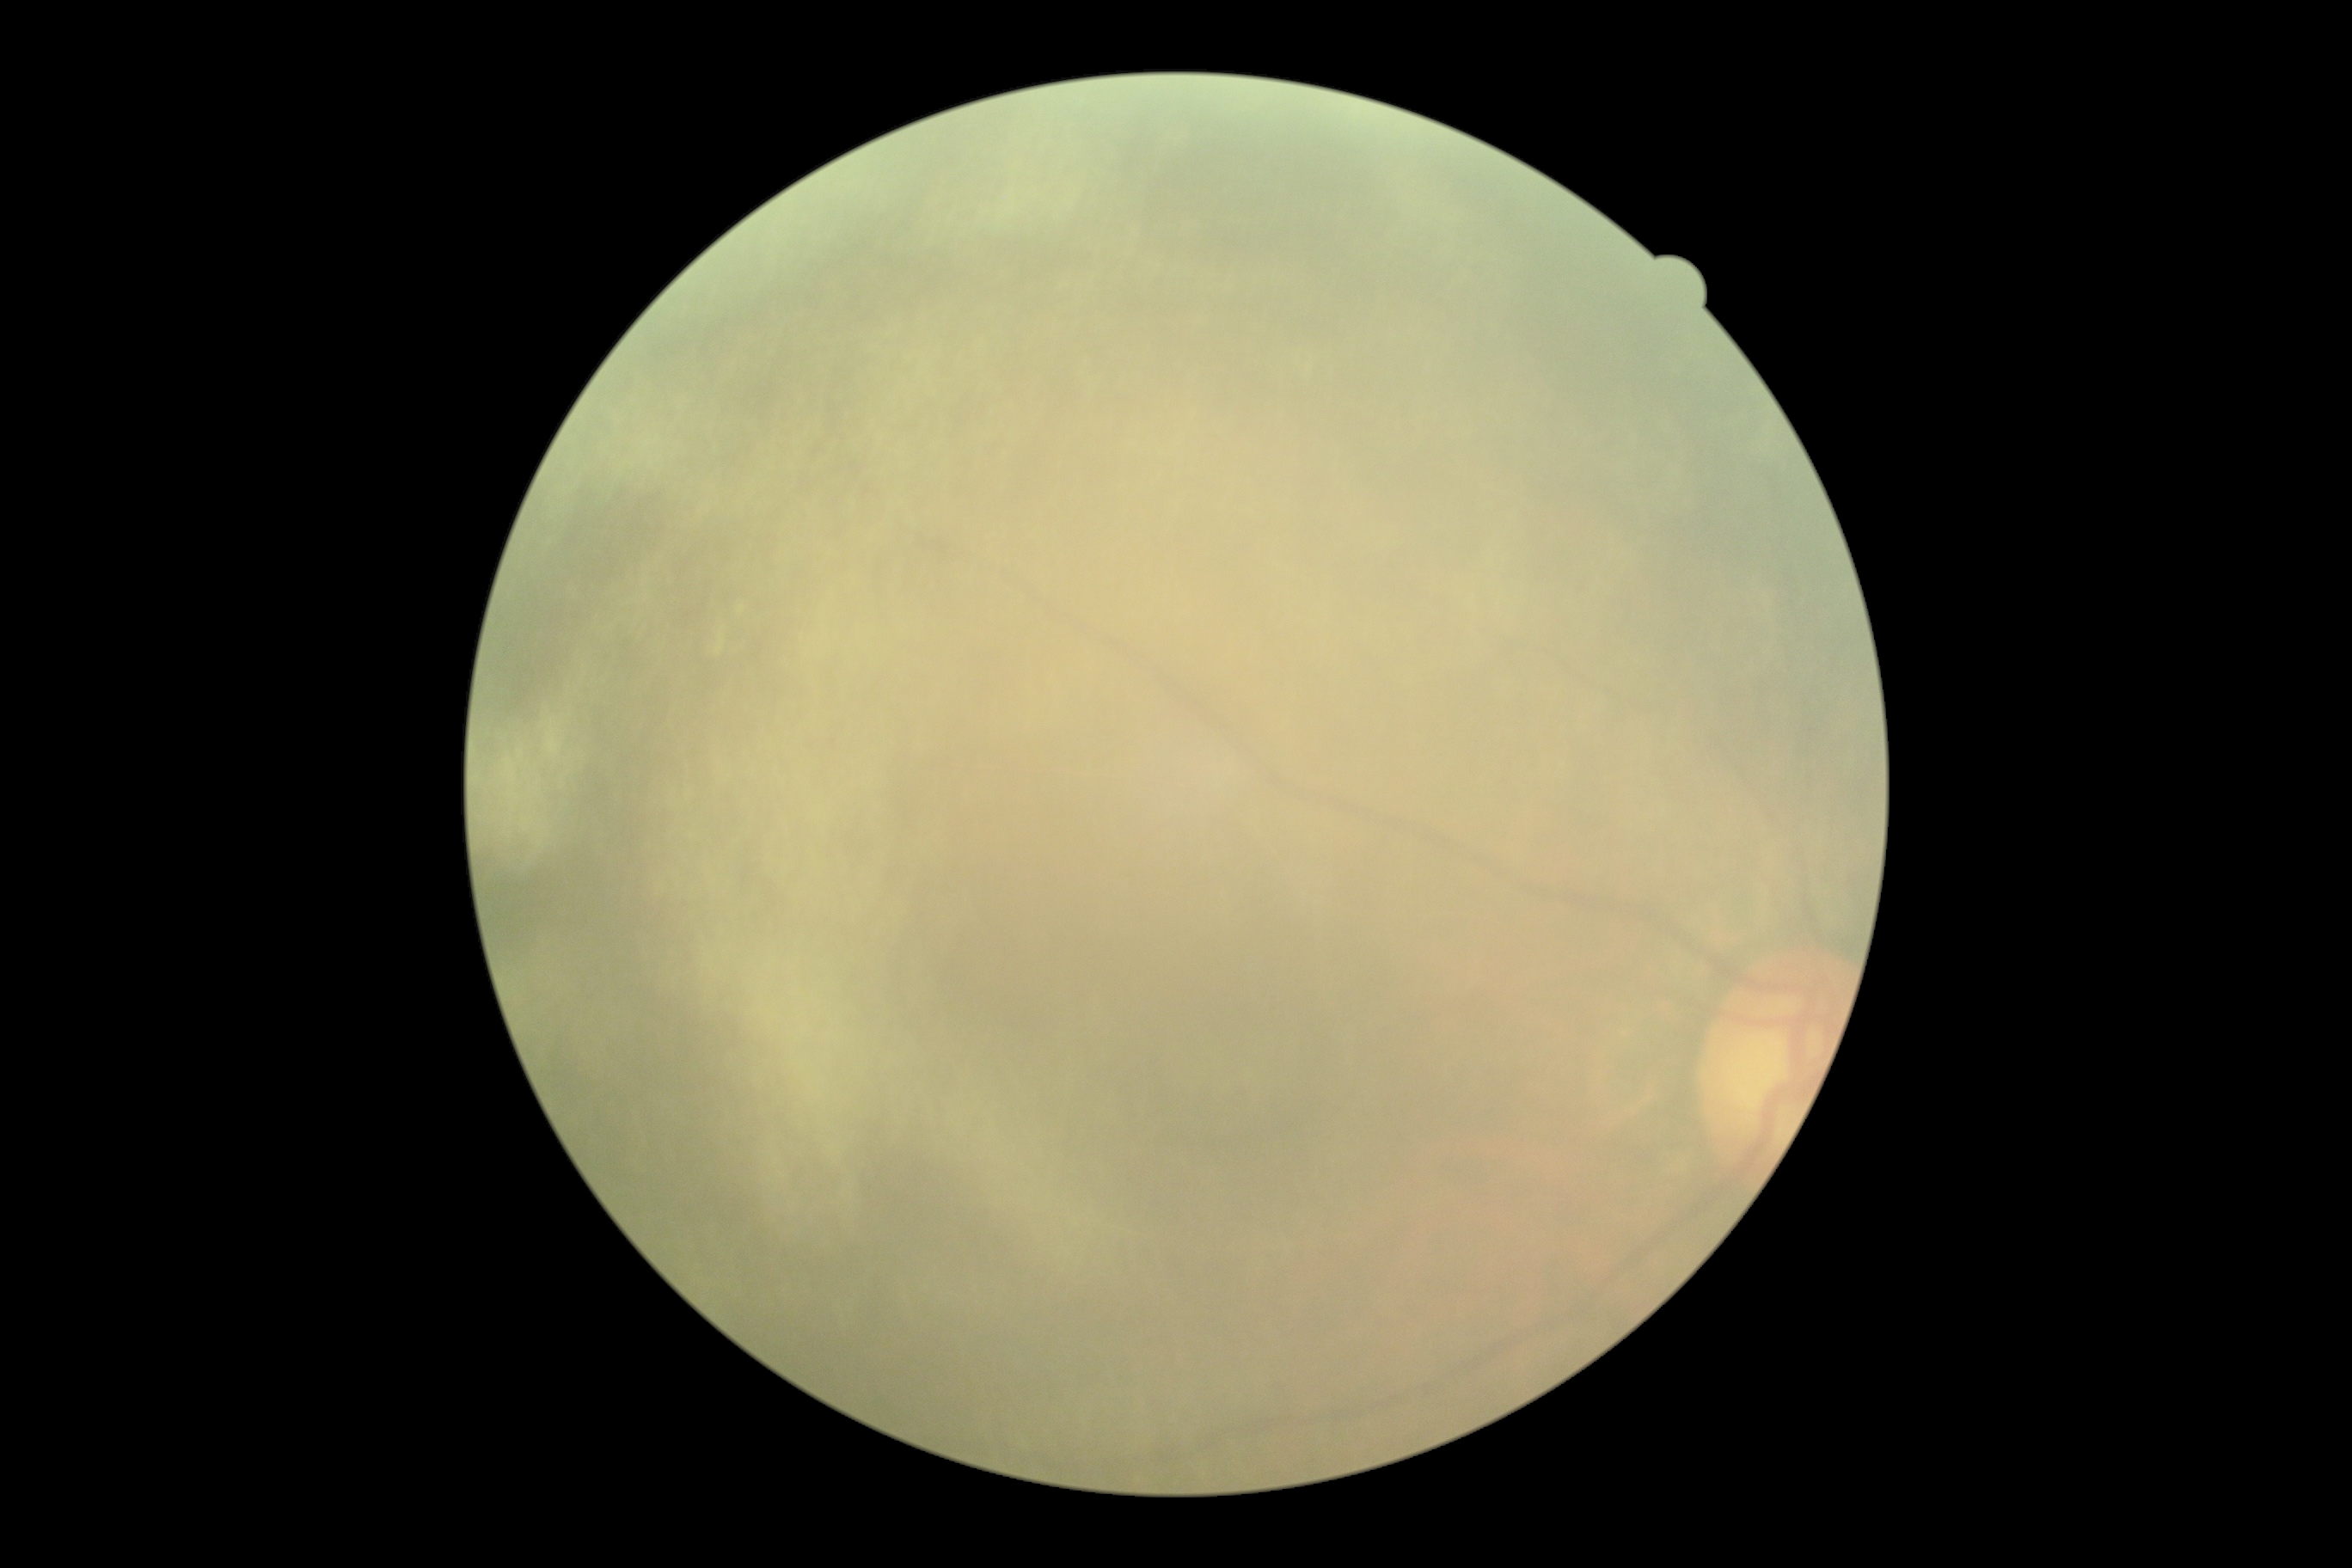 Diabetic retinopathy severity: ungradable.
Image quality is insufficient for diabetic retinopathy assessment.